Wide-field fundus photograph of an infant · acquired on the Phoenix ICON:
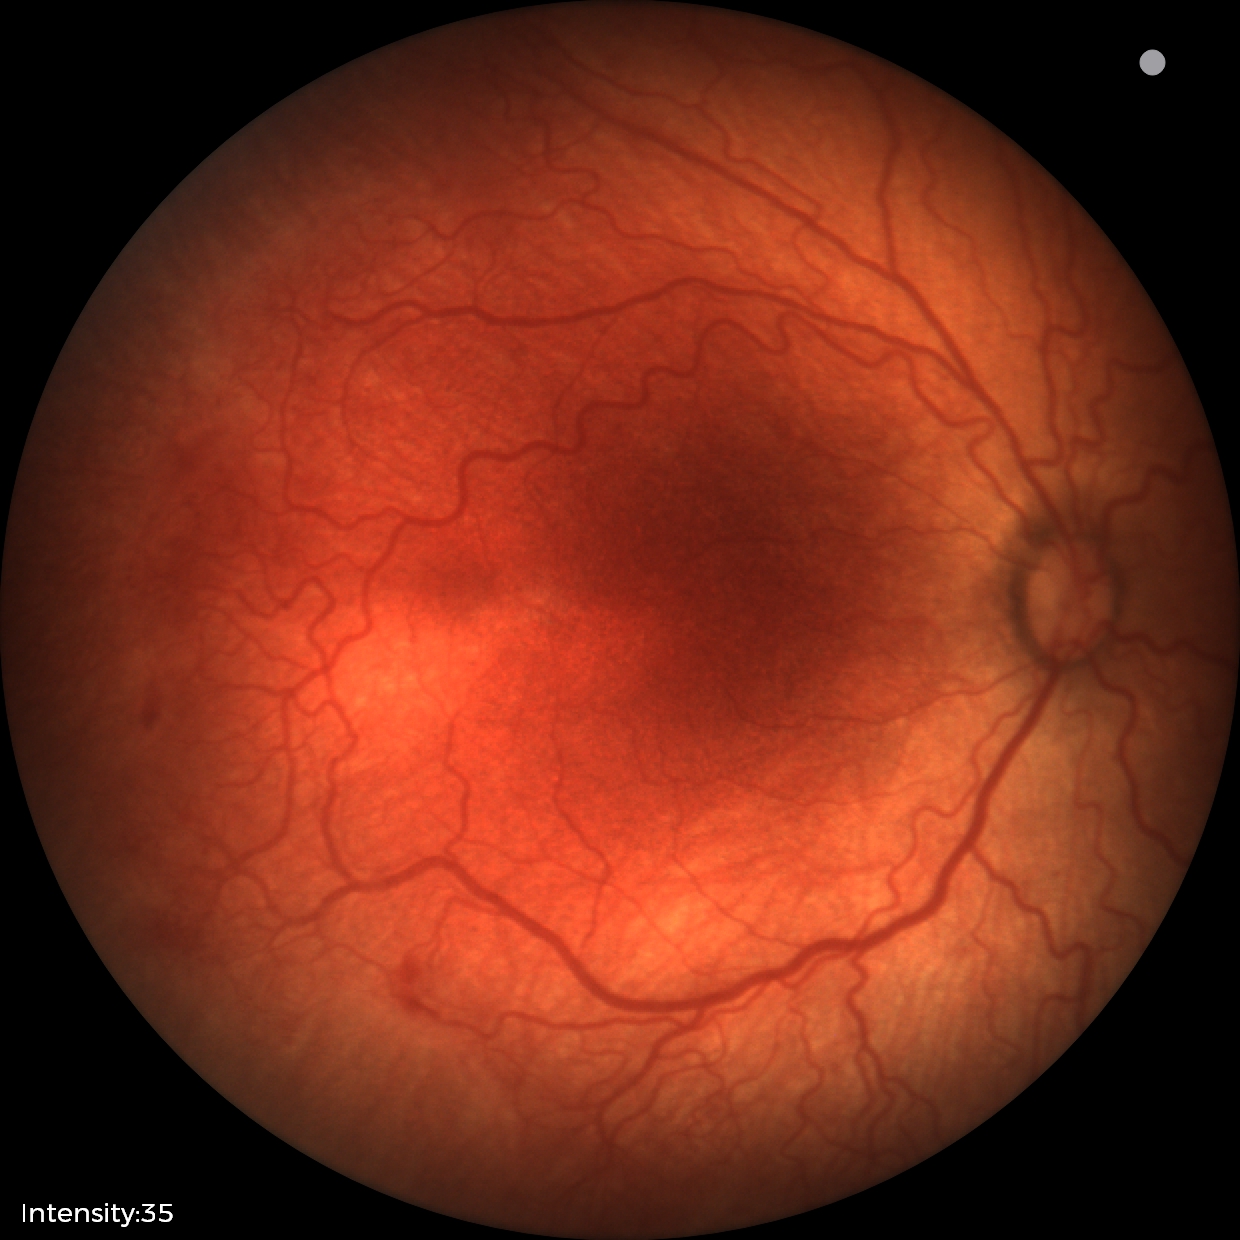

With plus disease. Diagnosis from this screening exam: retinopathy of prematurity stage 2 — ridge with height and width at the demarcation line.